Clarity RetCam 3, 130° FOV · wide-field contact fundus photograph of an infant — 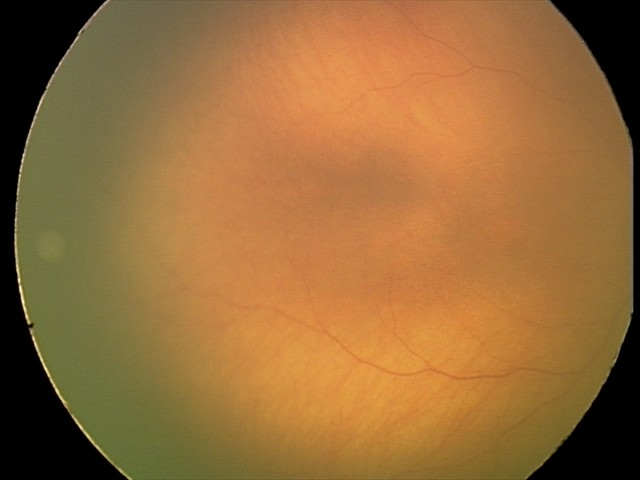

Examination with physiological retinal findings.